Tabletop color fundus camera image
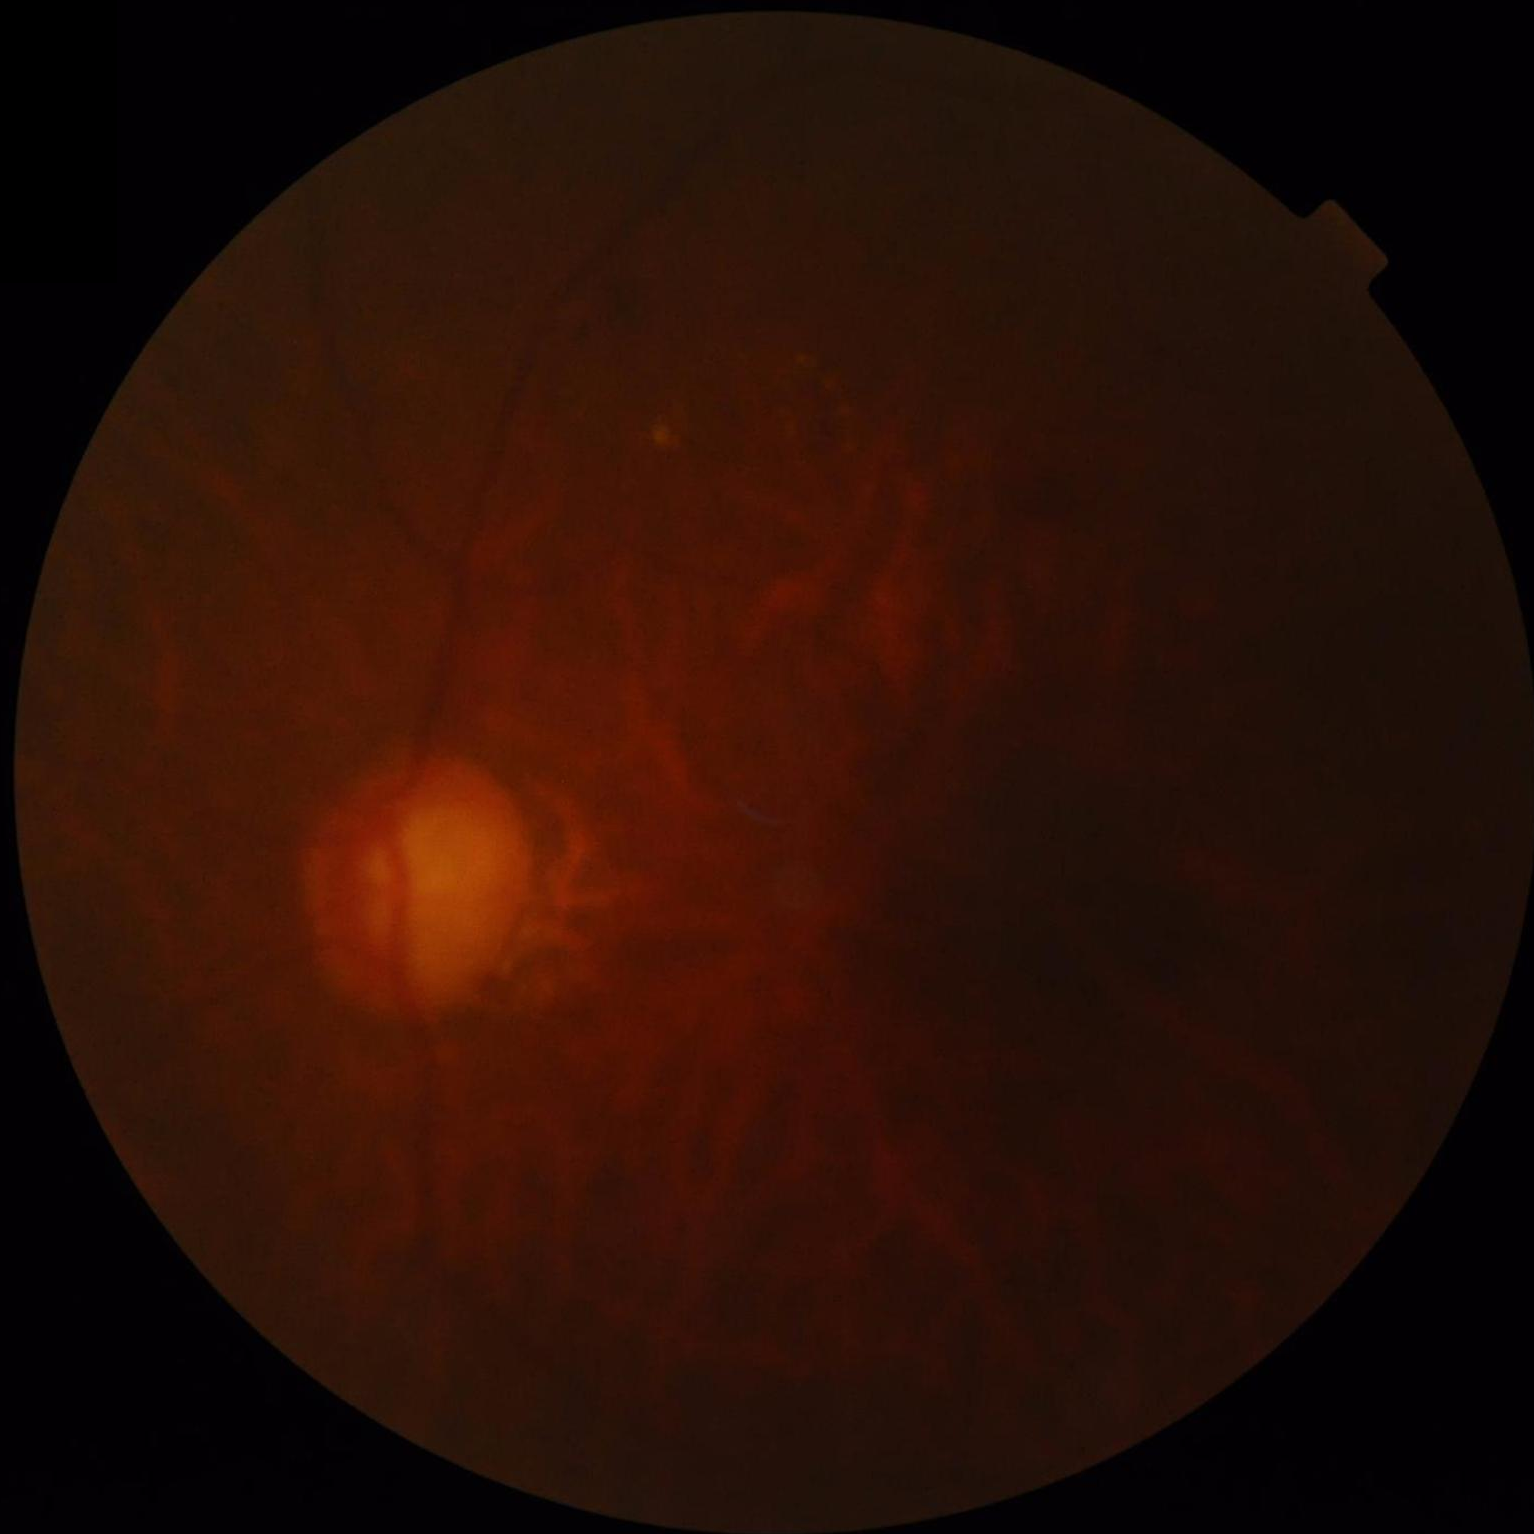

{
  "clarity": "out of focus",
  "overall_quality": "poor",
  "contrast": "low",
  "illumination": "poor"
}